45° field of view; CFP: 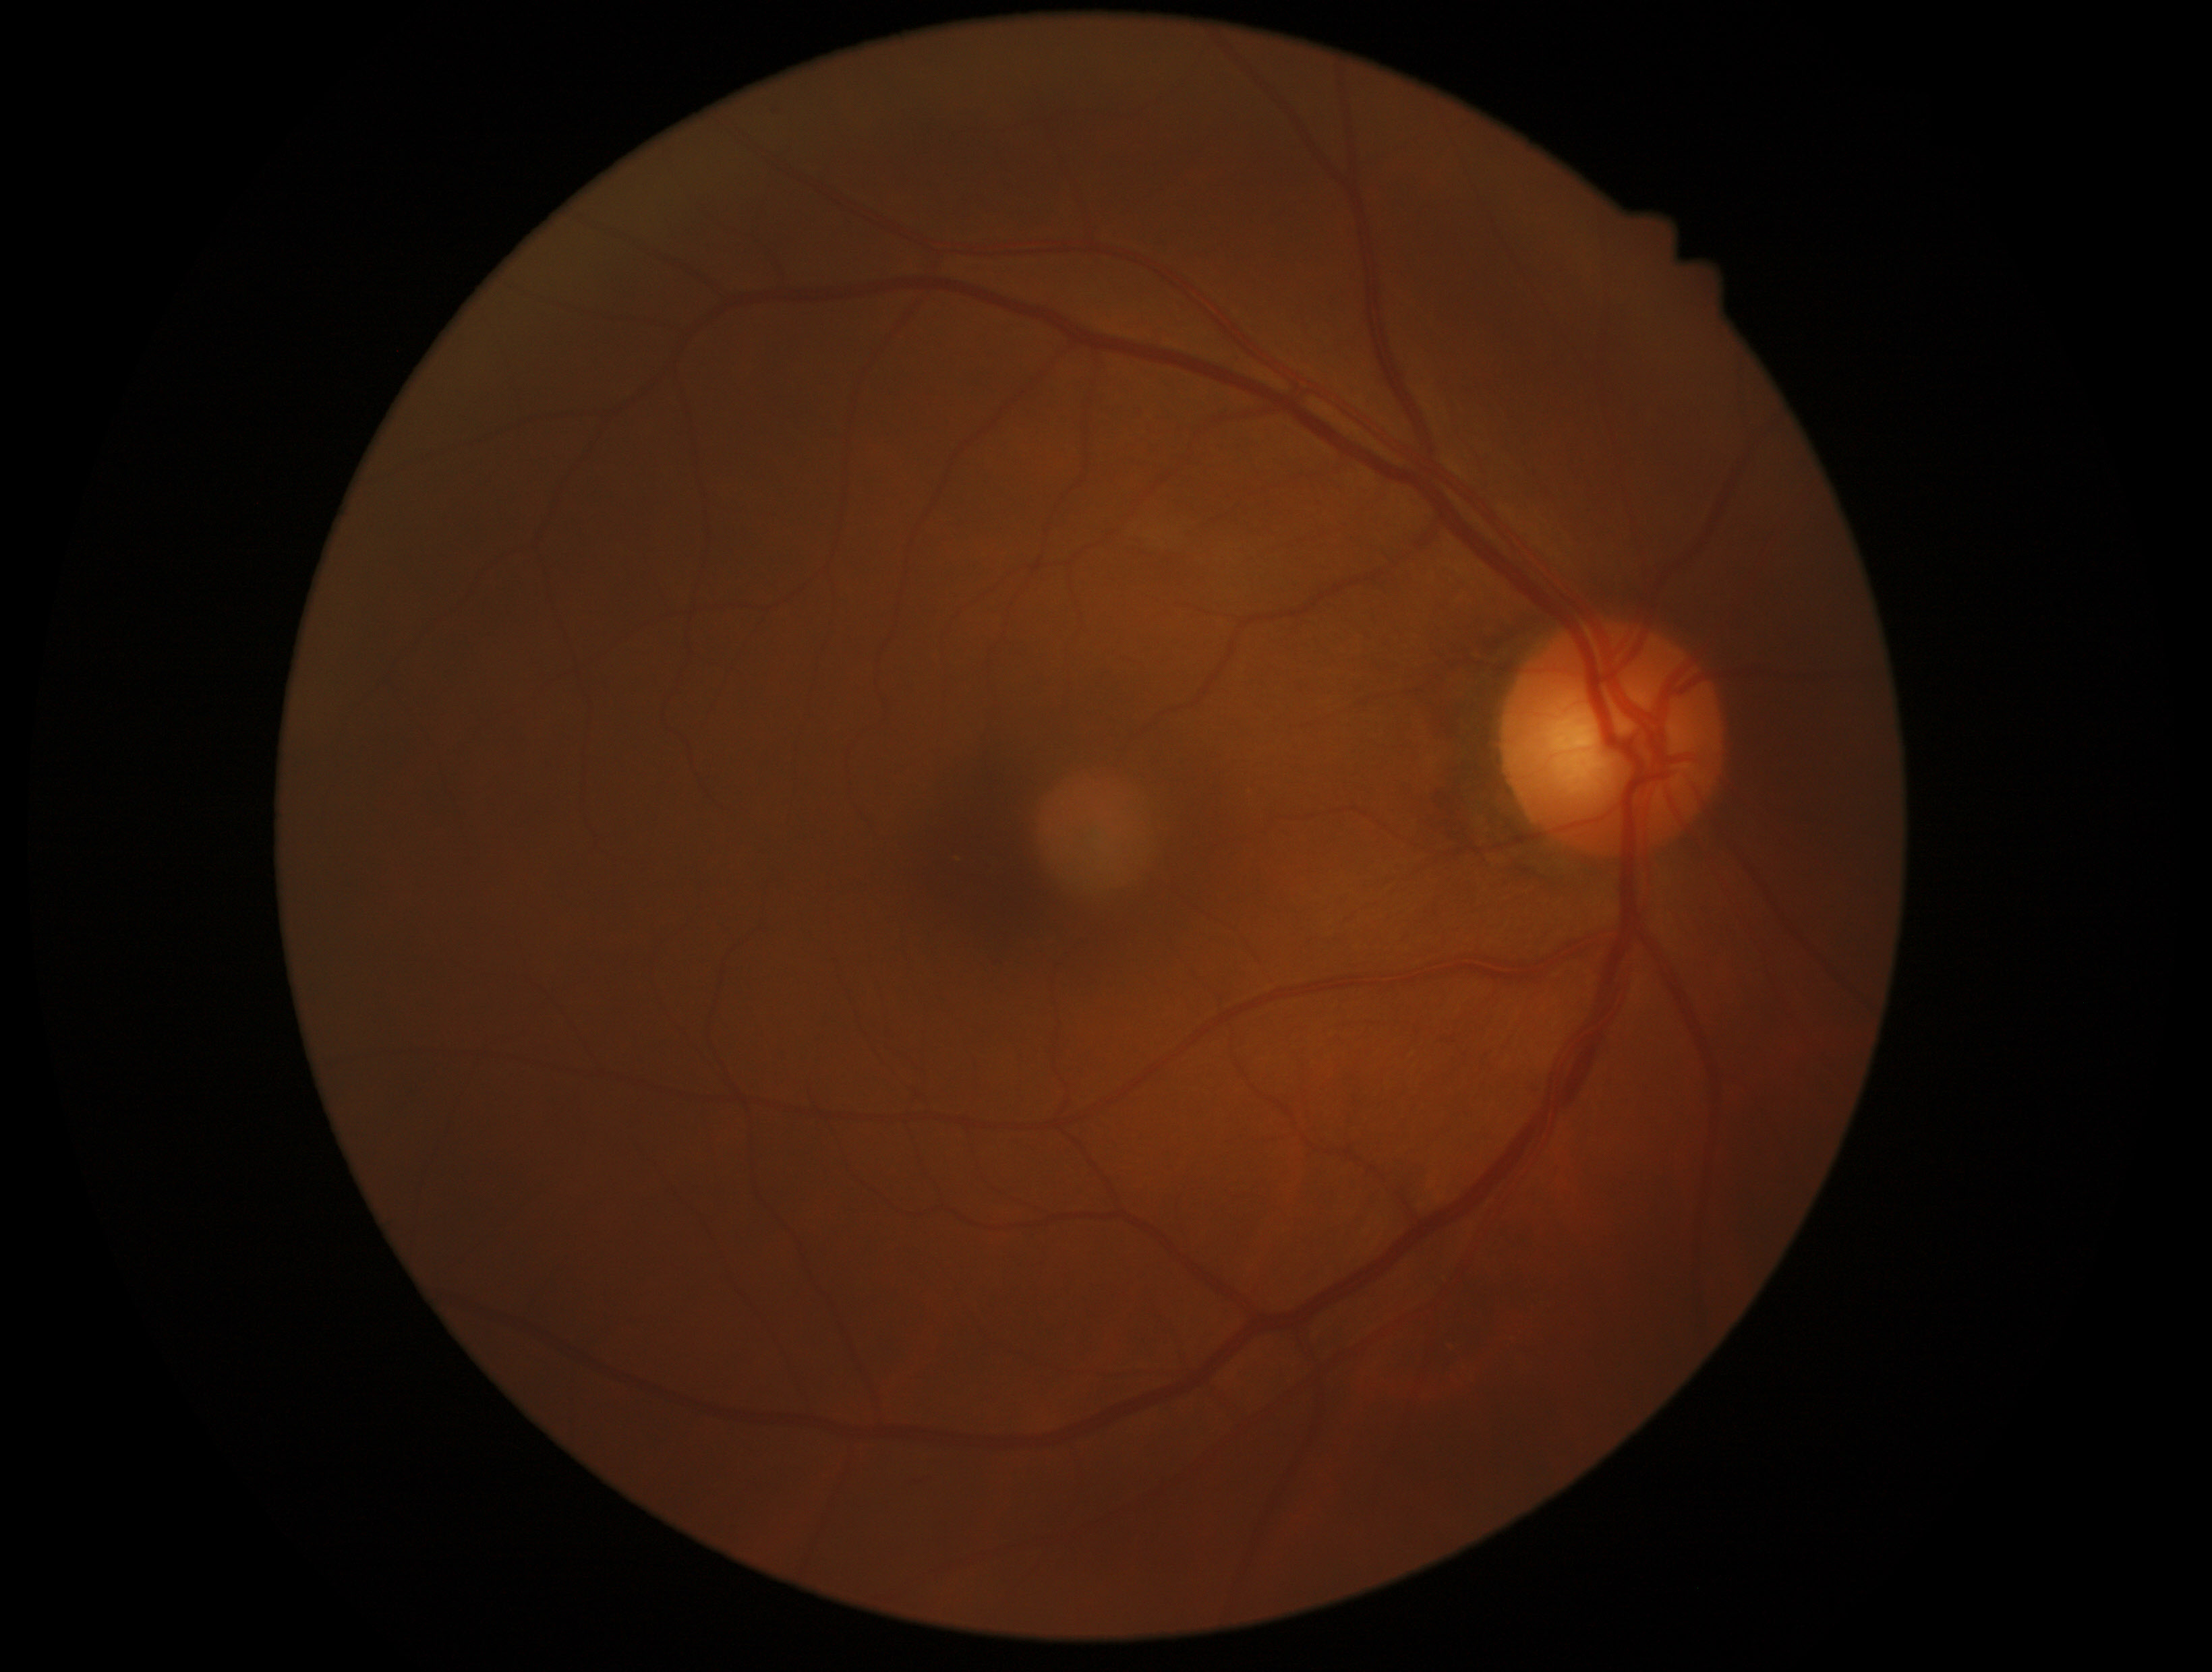 diabetic retinopathy severity: no apparent diabetic retinopathy (grade 0) — no visible signs of diabetic retinopathy; DR impression: no apparent DR.